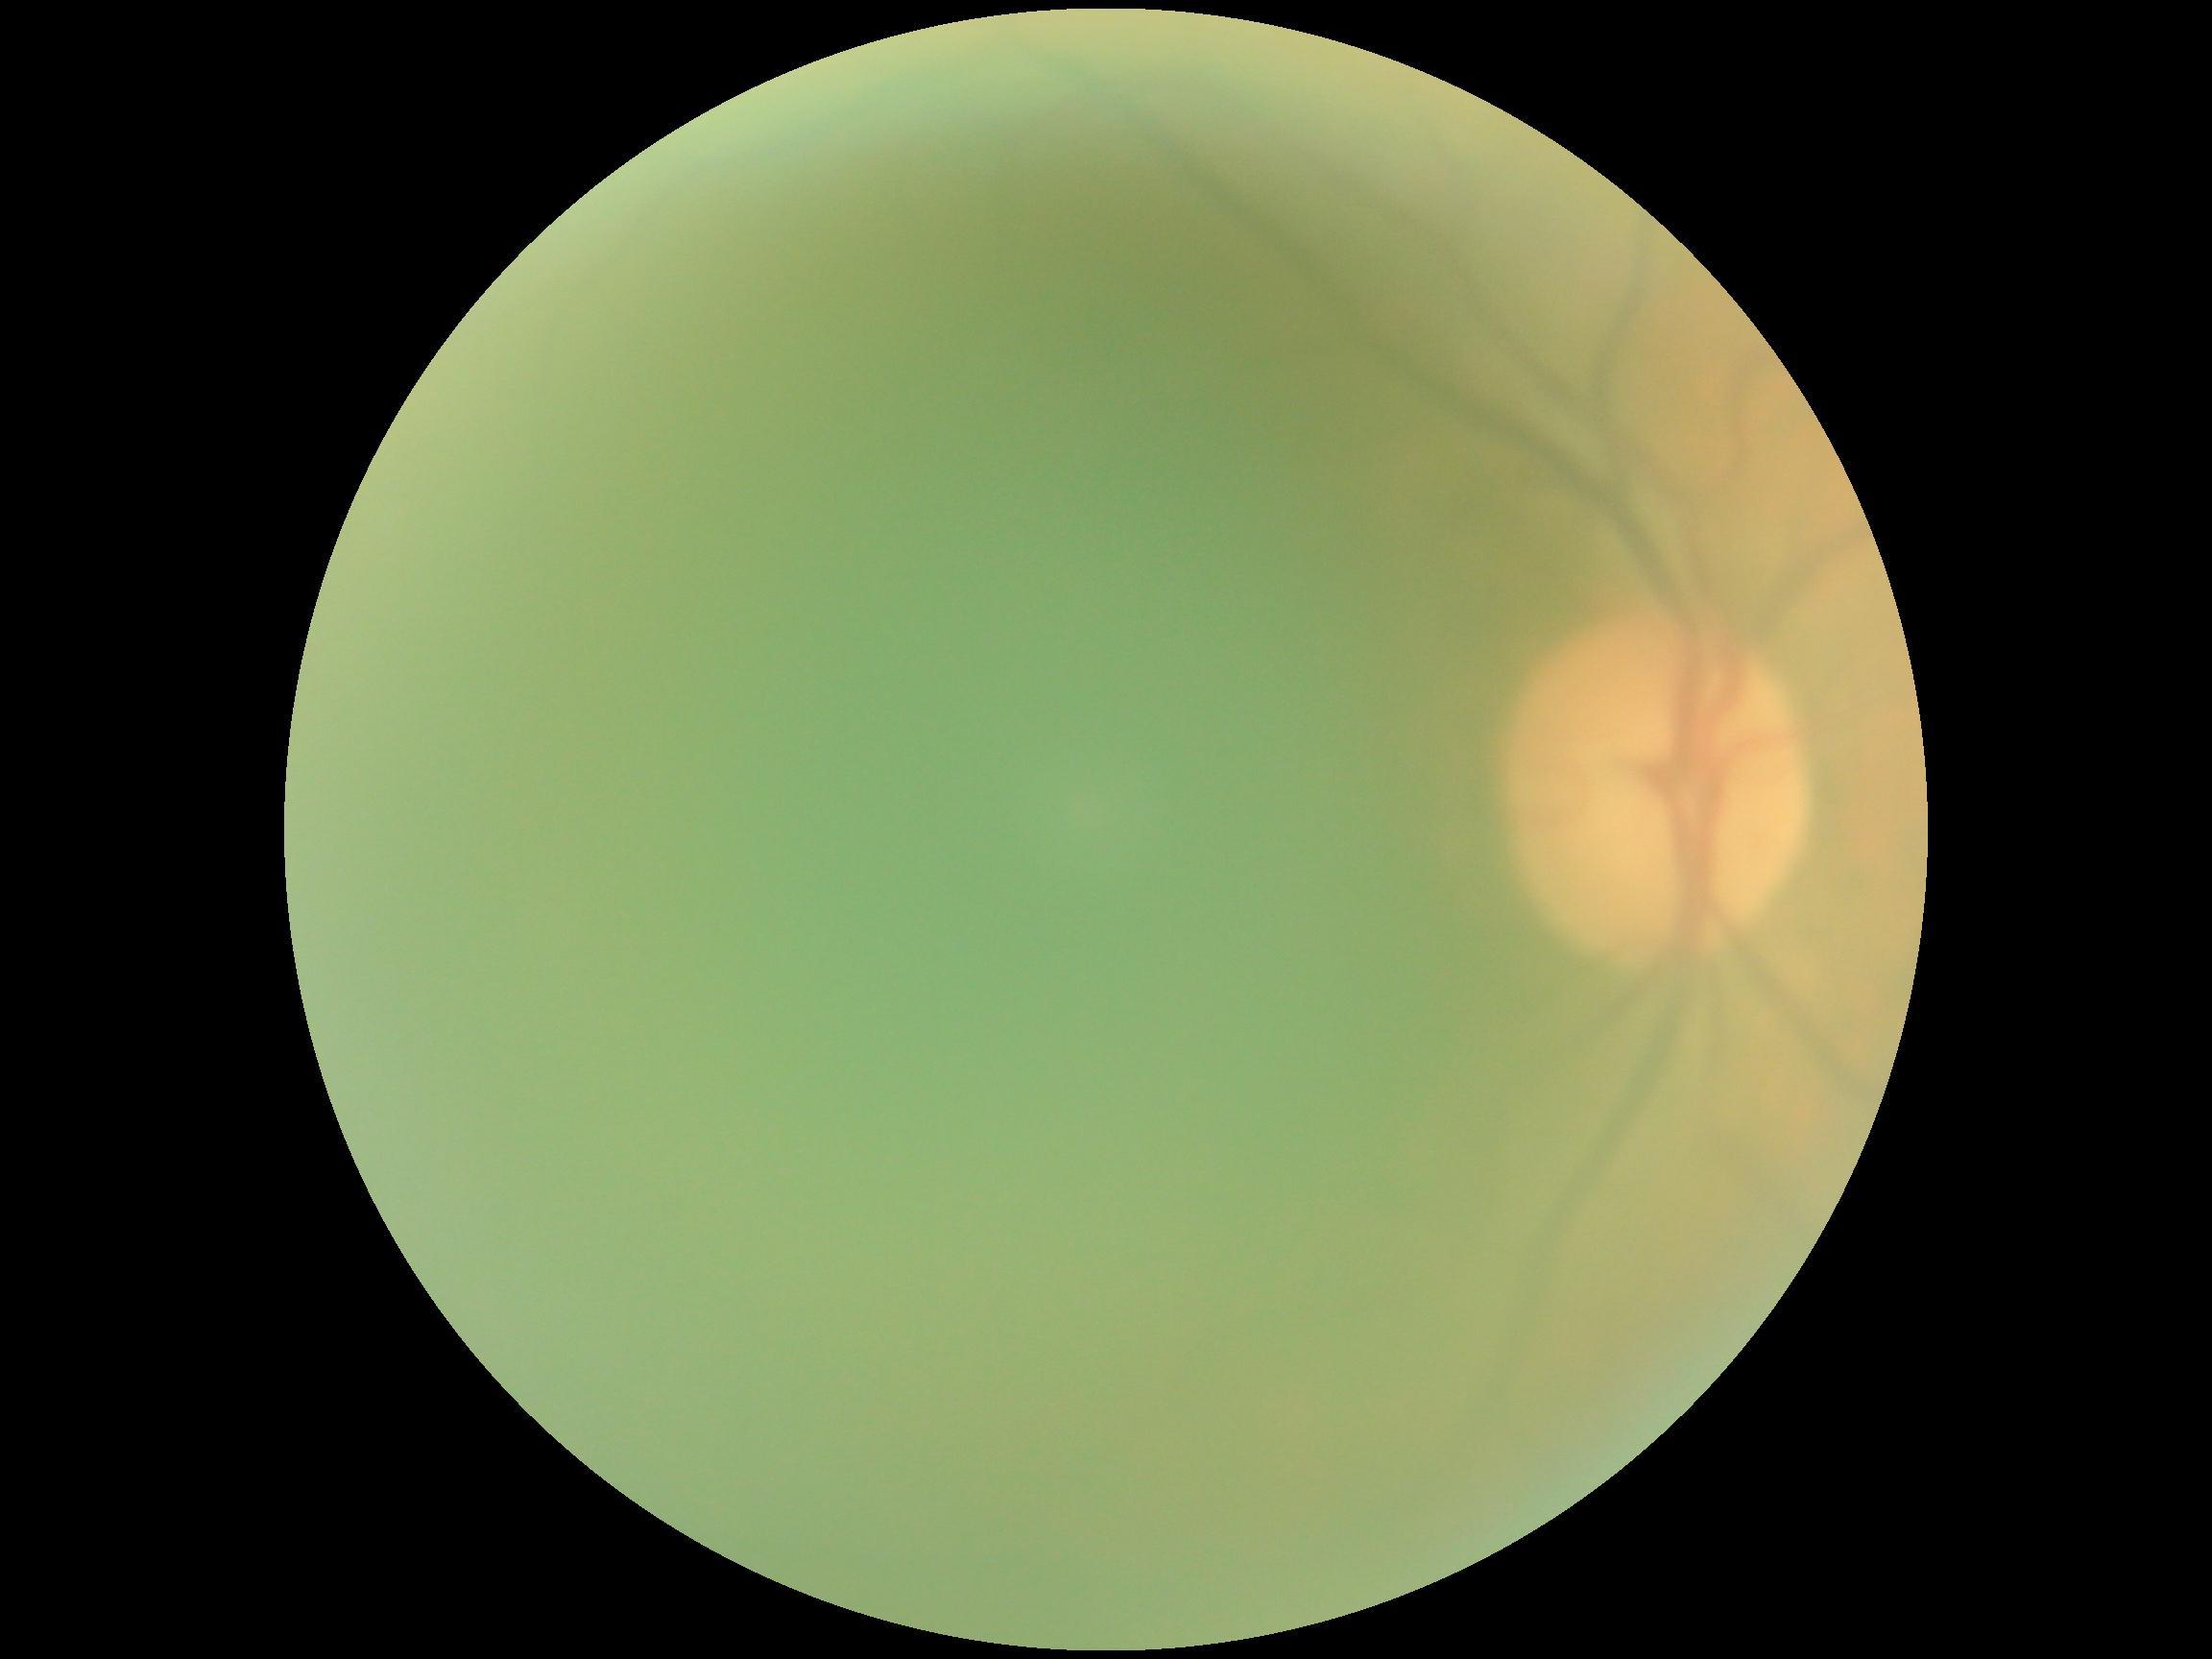 DR grade is ungradable due to poor image quality.
Quality too poor to assess for DR.